Infant wide-field fundus photograph · 640x480 · camera: Clarity RetCam 3 (130° FOV) — 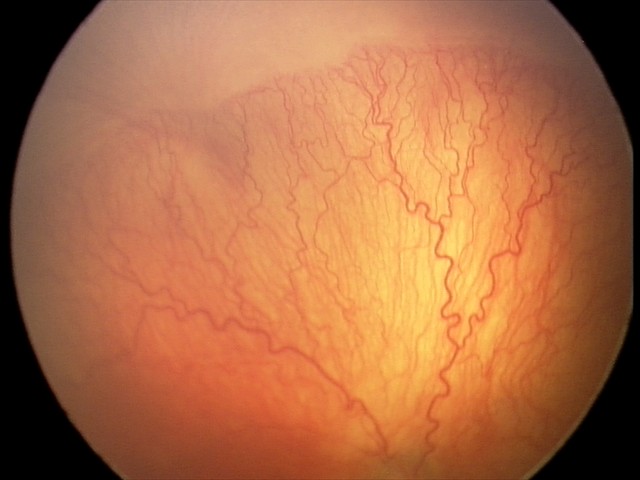 Series diagnosed as A-ROP (aggressive ROP) — rapidly progressive severe ROP with prominent plus disease, often without classic stage progression.